Wide-field fundus photograph of an infant. 640x480:
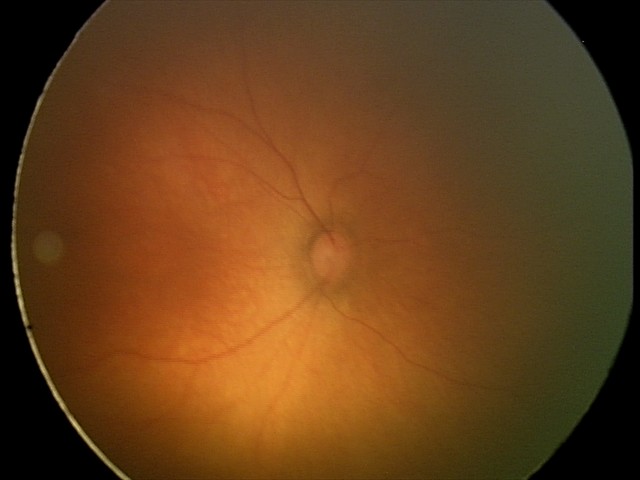

Screening examination with no abnormal retinal findings.